Color fundus image: 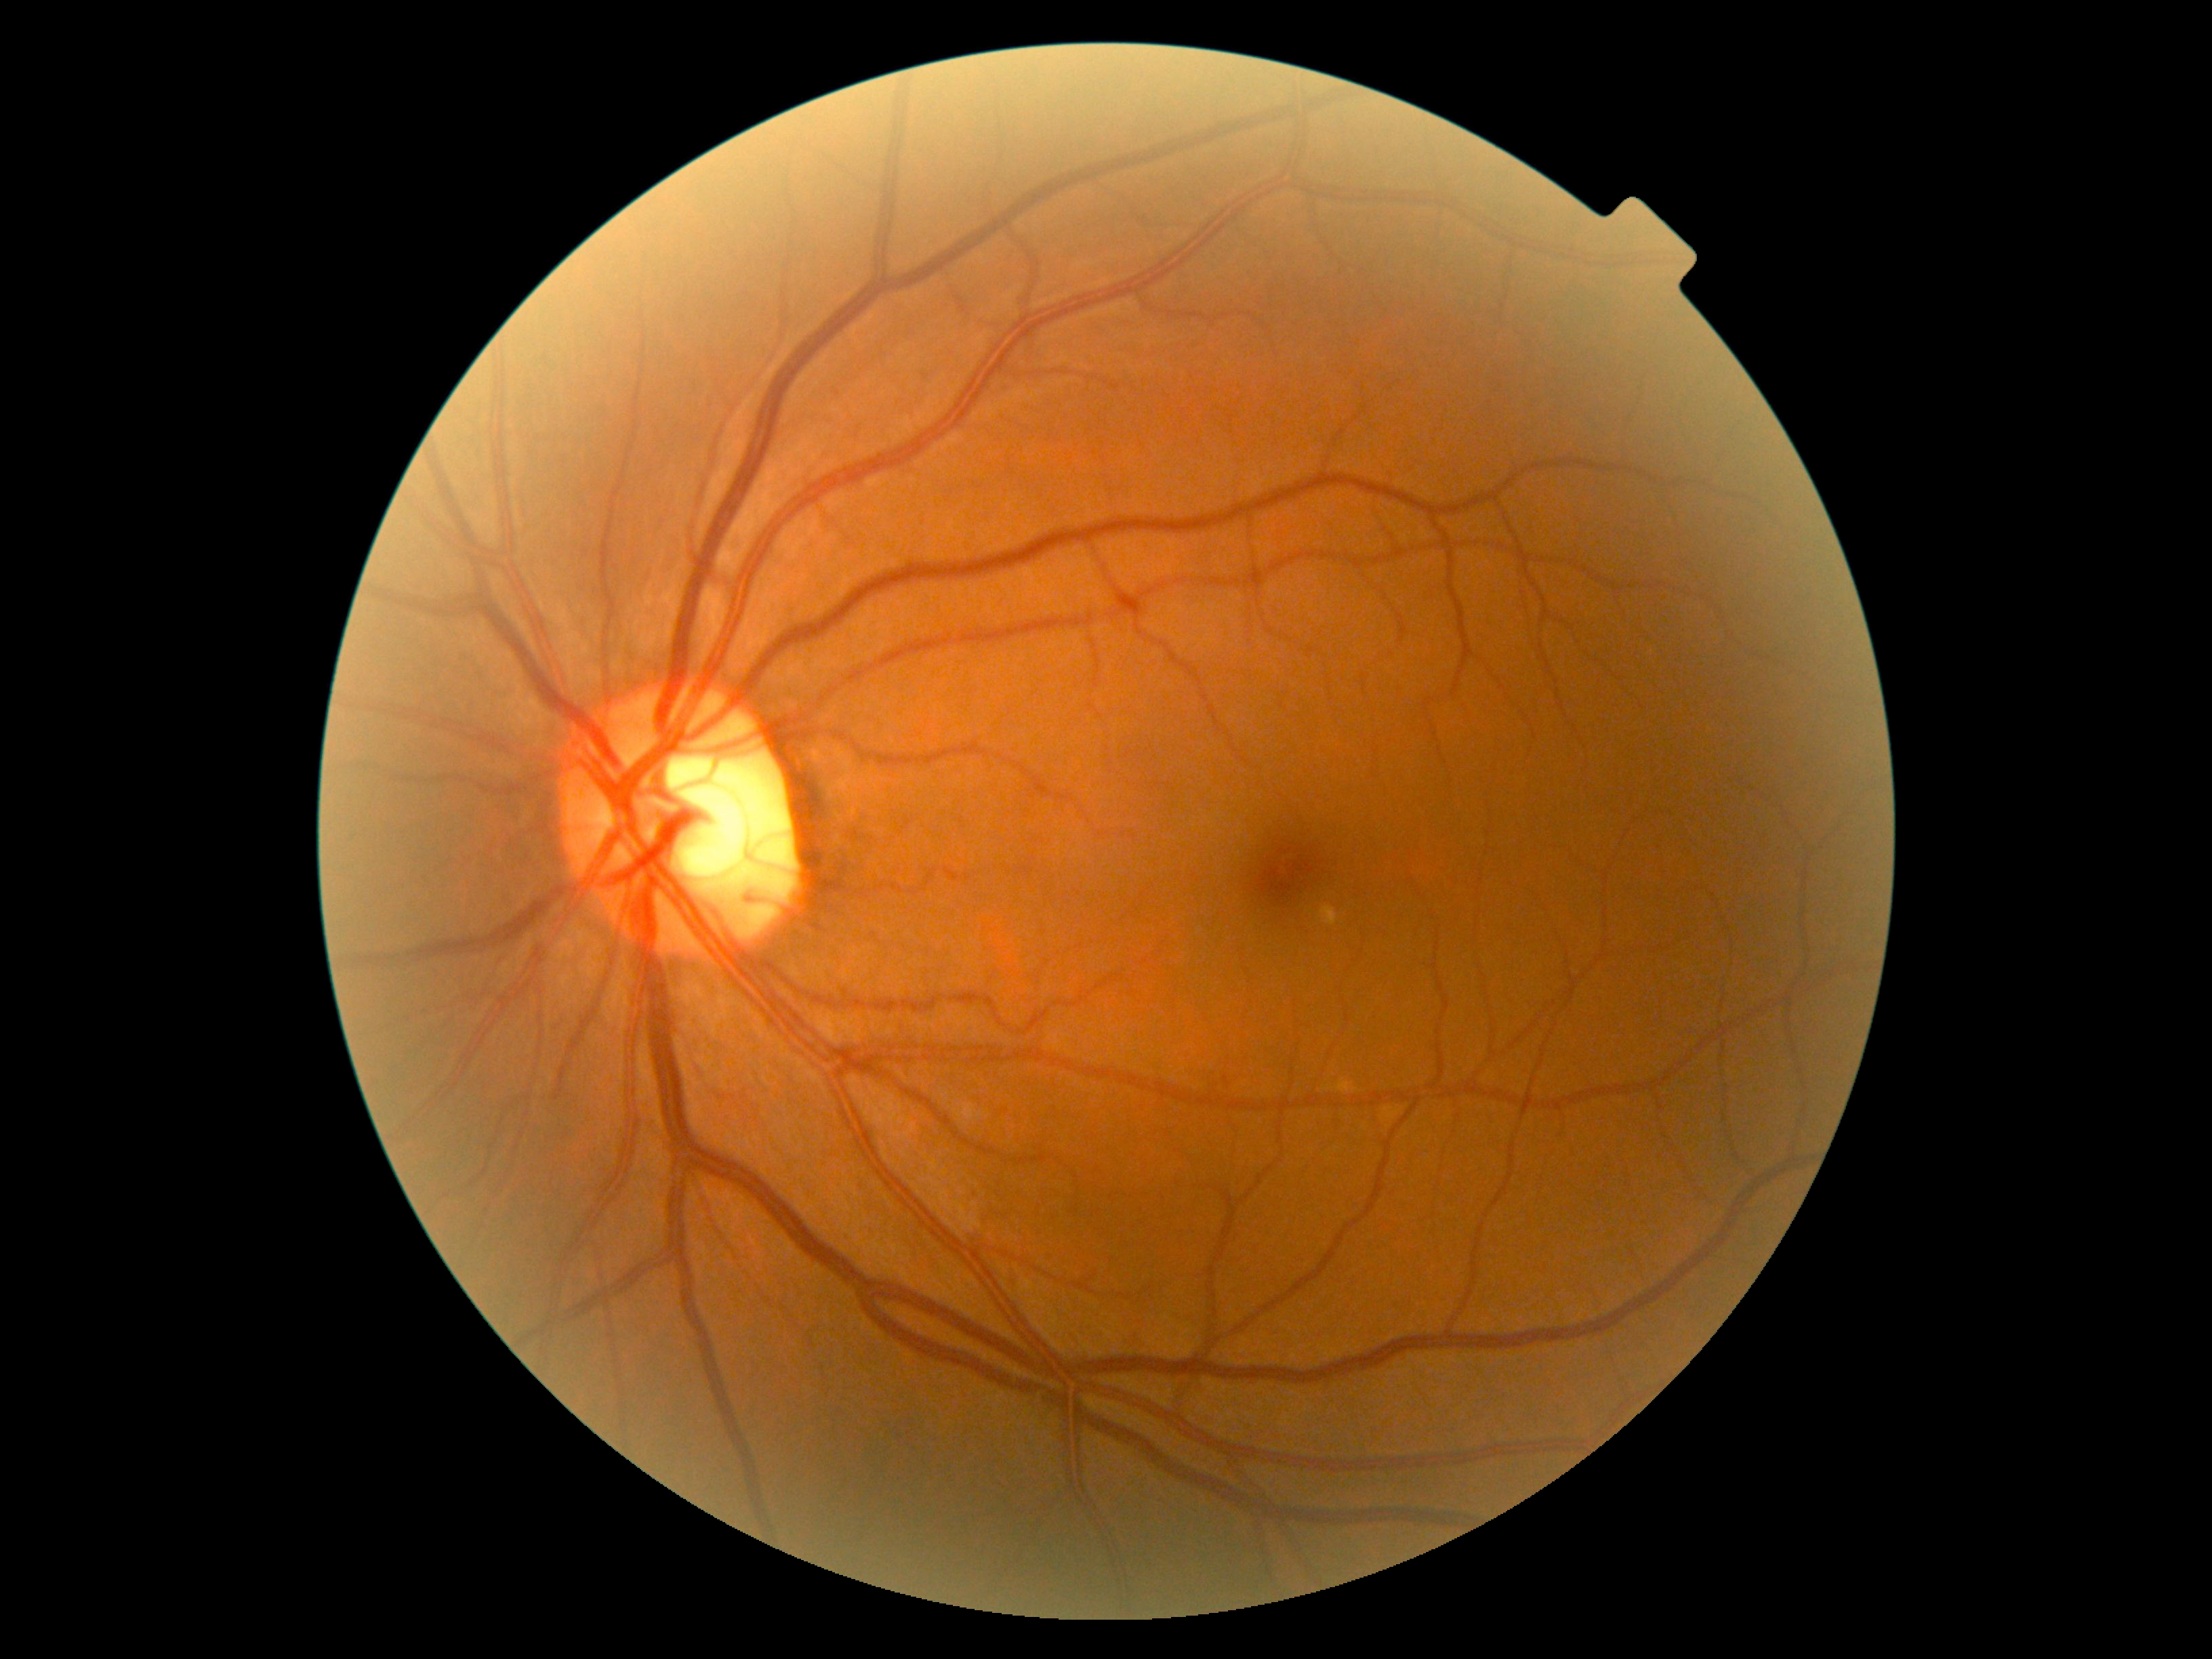
DR stage: grade 0 (no apparent retinopathy) — no visible signs of diabetic retinopathy.